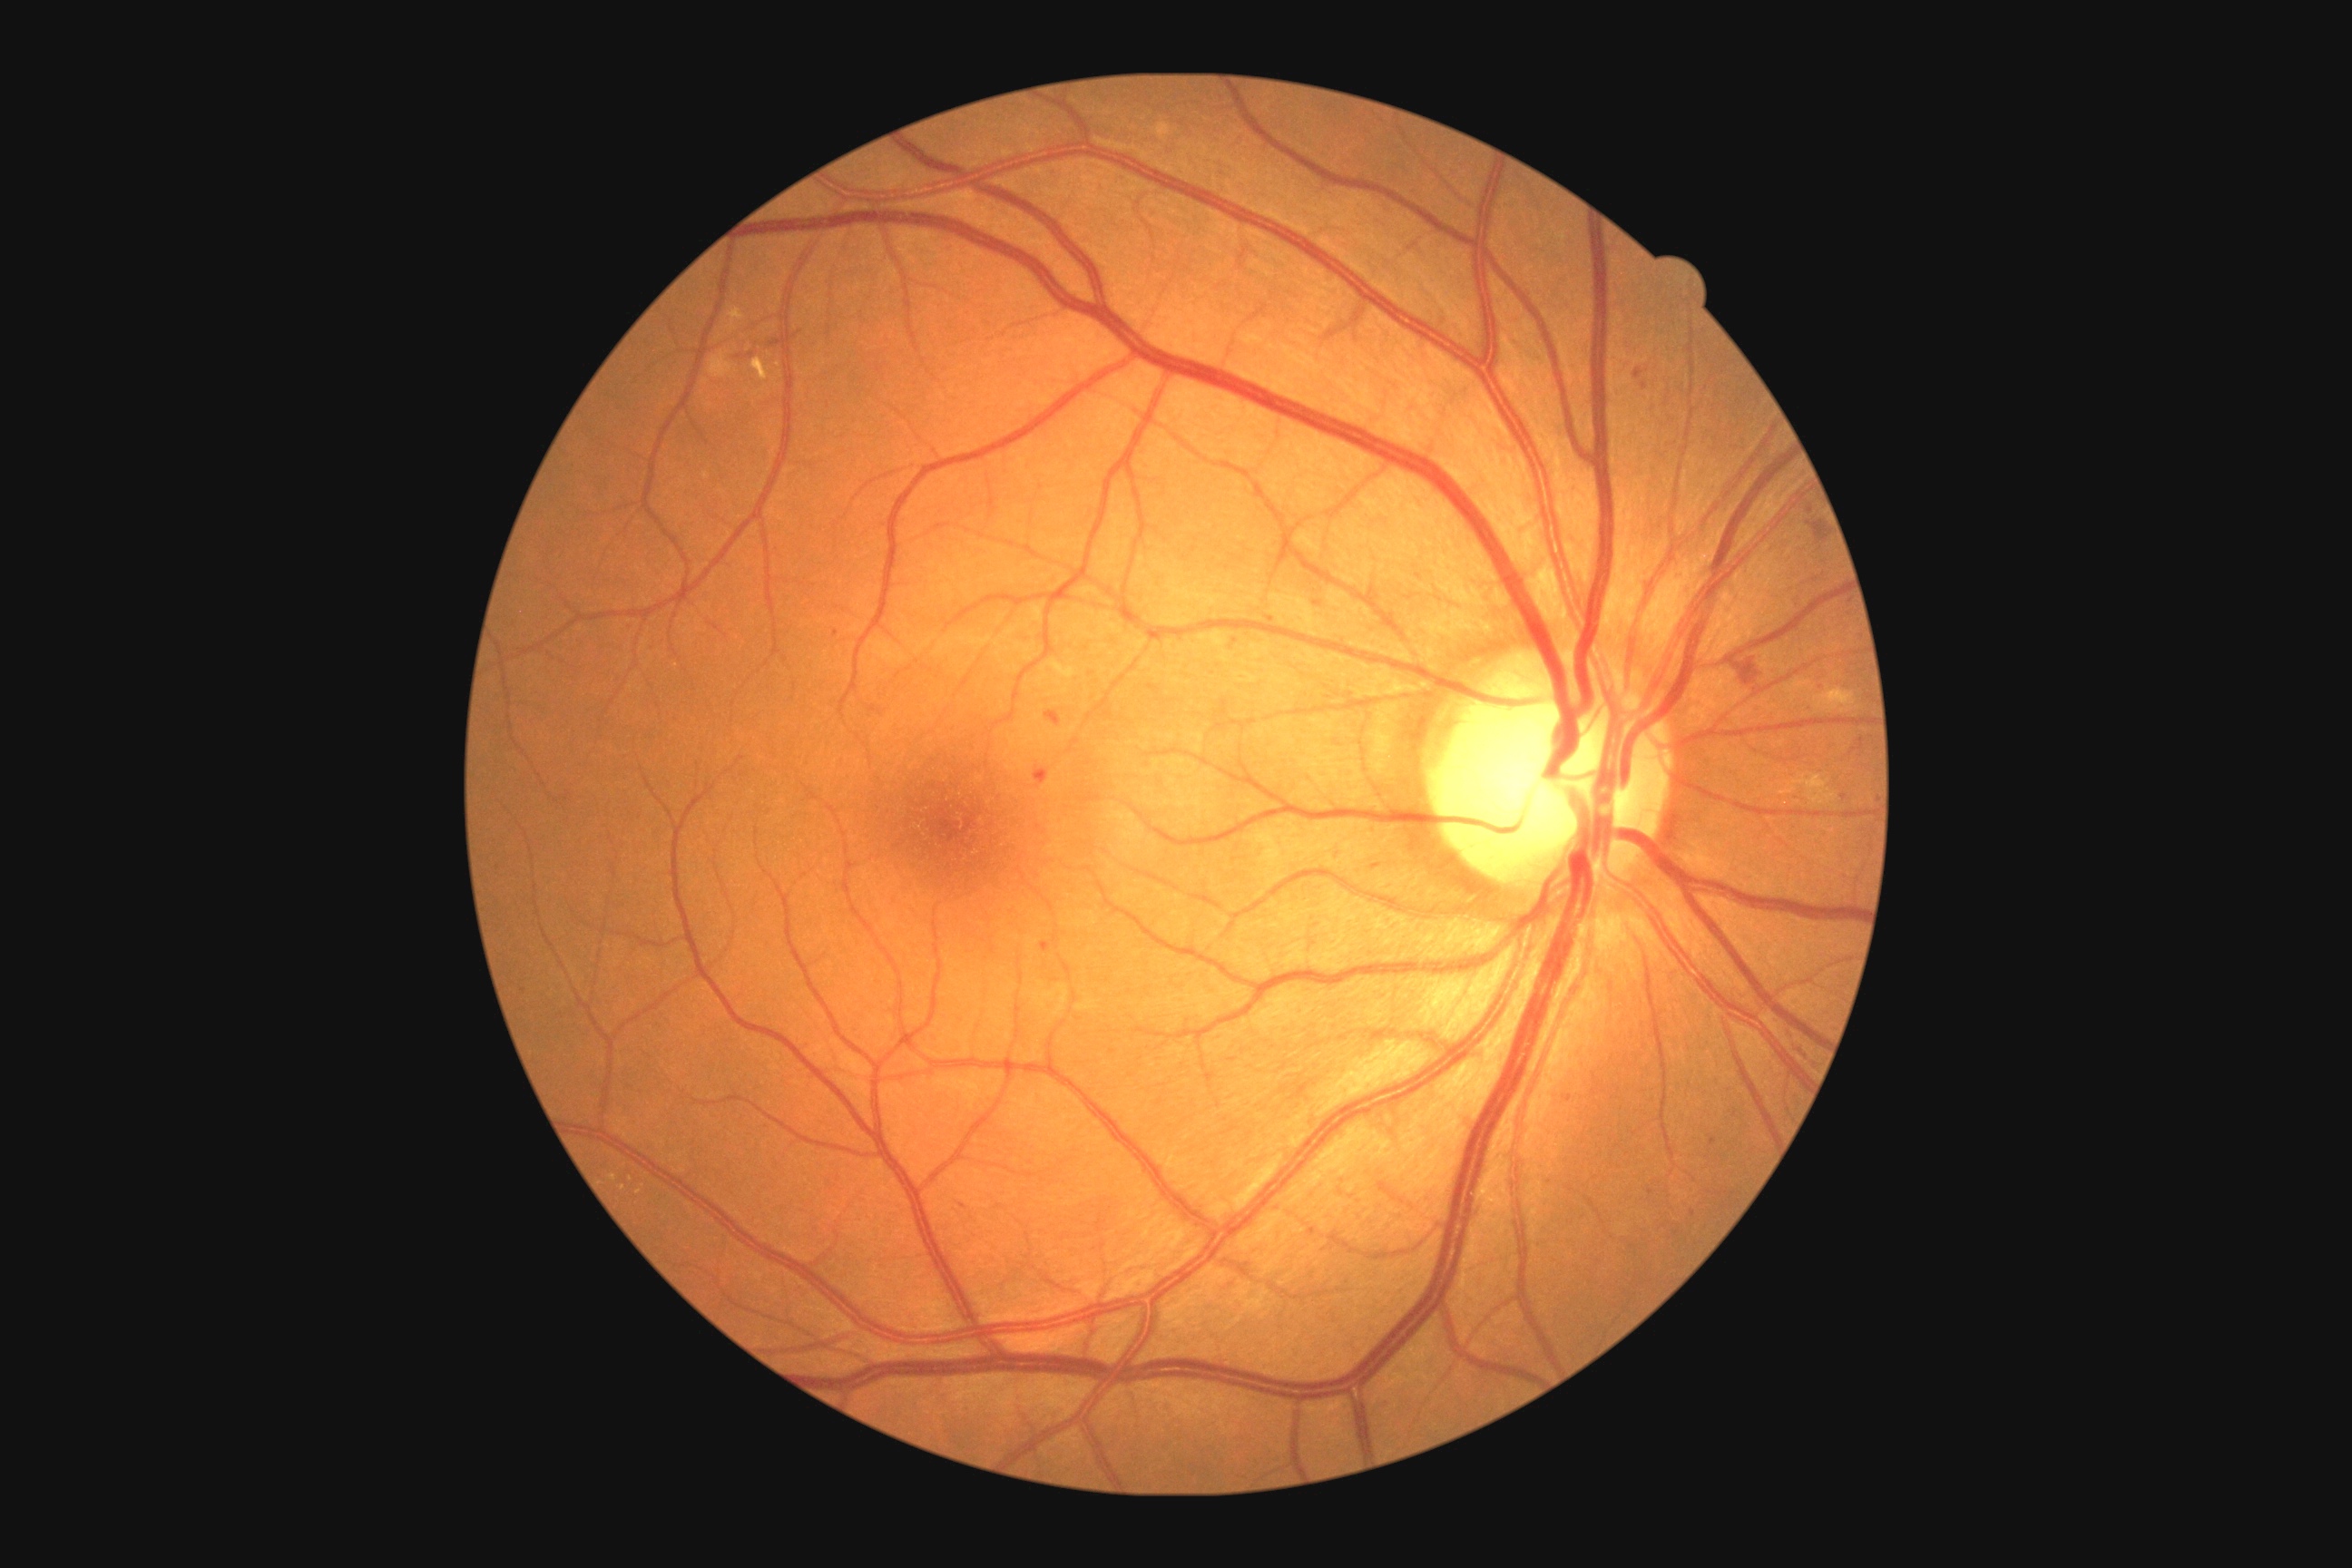
Retinopathy grade is 2 (moderate NPDR)
Representative lesions:
• soft exudates: not present
• microaneurysms (continued): (left=1636, top=369, right=1643, bottom=378) | (left=1313, top=602, right=1322, bottom=607) | (left=1852, top=738, right=1865, bottom=754)
• Small microaneurysms approximately at x=1844, y=798 | x=1152, y=211 | x=1712, y=1142 | x=1800, y=604 | x=1569, y=1099 | x=1232, y=648 | x=1677, y=1233 | x=1236, y=641
• hemorrhages: (left=1807, top=522, right=1828, bottom=544) | (left=1734, top=658, right=1761, bottom=687) | (left=1044, top=710, right=1063, bottom=727) | (left=1034, top=767, right=1050, bottom=789)
• hard exudates (continued): (left=1814, top=687, right=1856, bottom=712) | (left=709, top=351, right=736, bottom=378) | (left=1787, top=680, right=1816, bottom=692) | (left=1781, top=785, right=1798, bottom=796) | (left=729, top=309, right=745, bottom=331) | (left=1153, top=124, right=1171, bottom=142) | (left=609, top=1175, right=618, bottom=1182) | (left=752, top=358, right=769, bottom=382) | (left=1794, top=774, right=1838, bottom=805)
• Small hard exudates approximately at x=623, y=1188 | x=639, y=1192